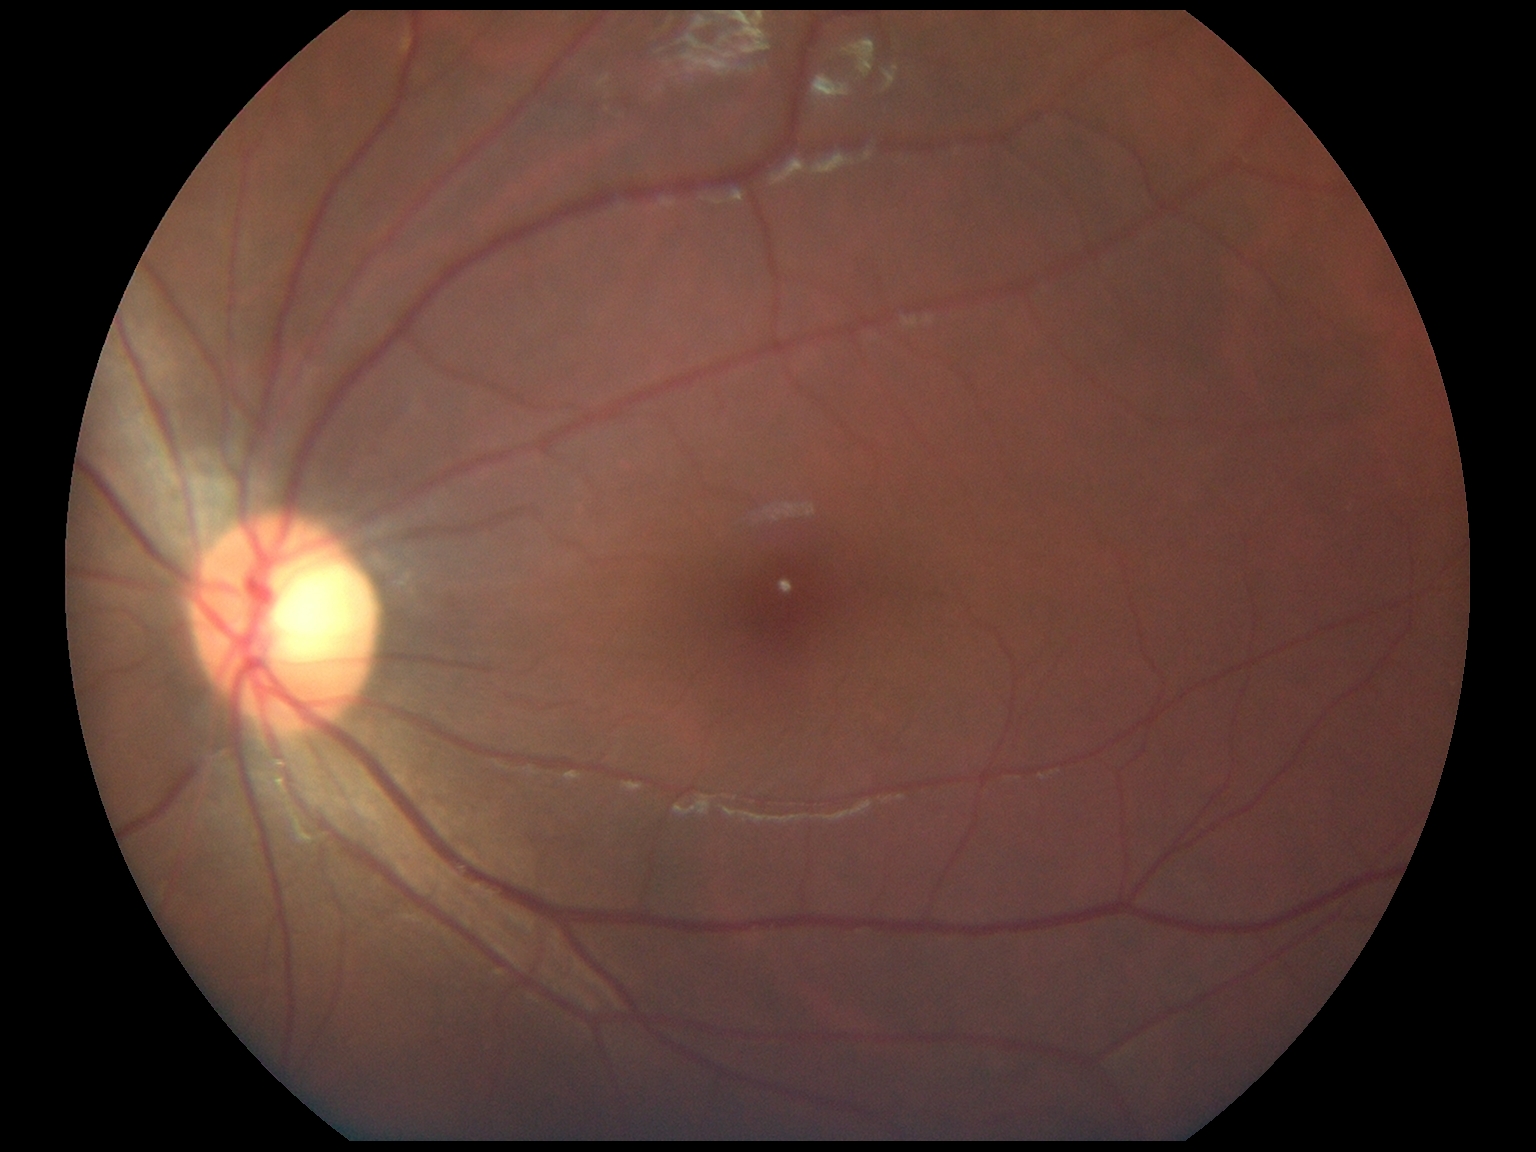 Diabetic retinopathy: grade 0 (no apparent retinopathy).